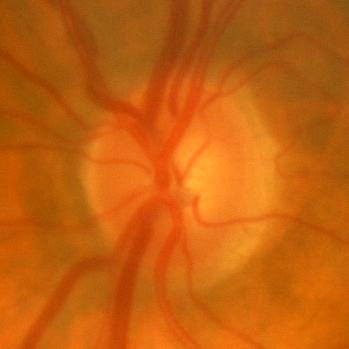

No glaucomatous damage.